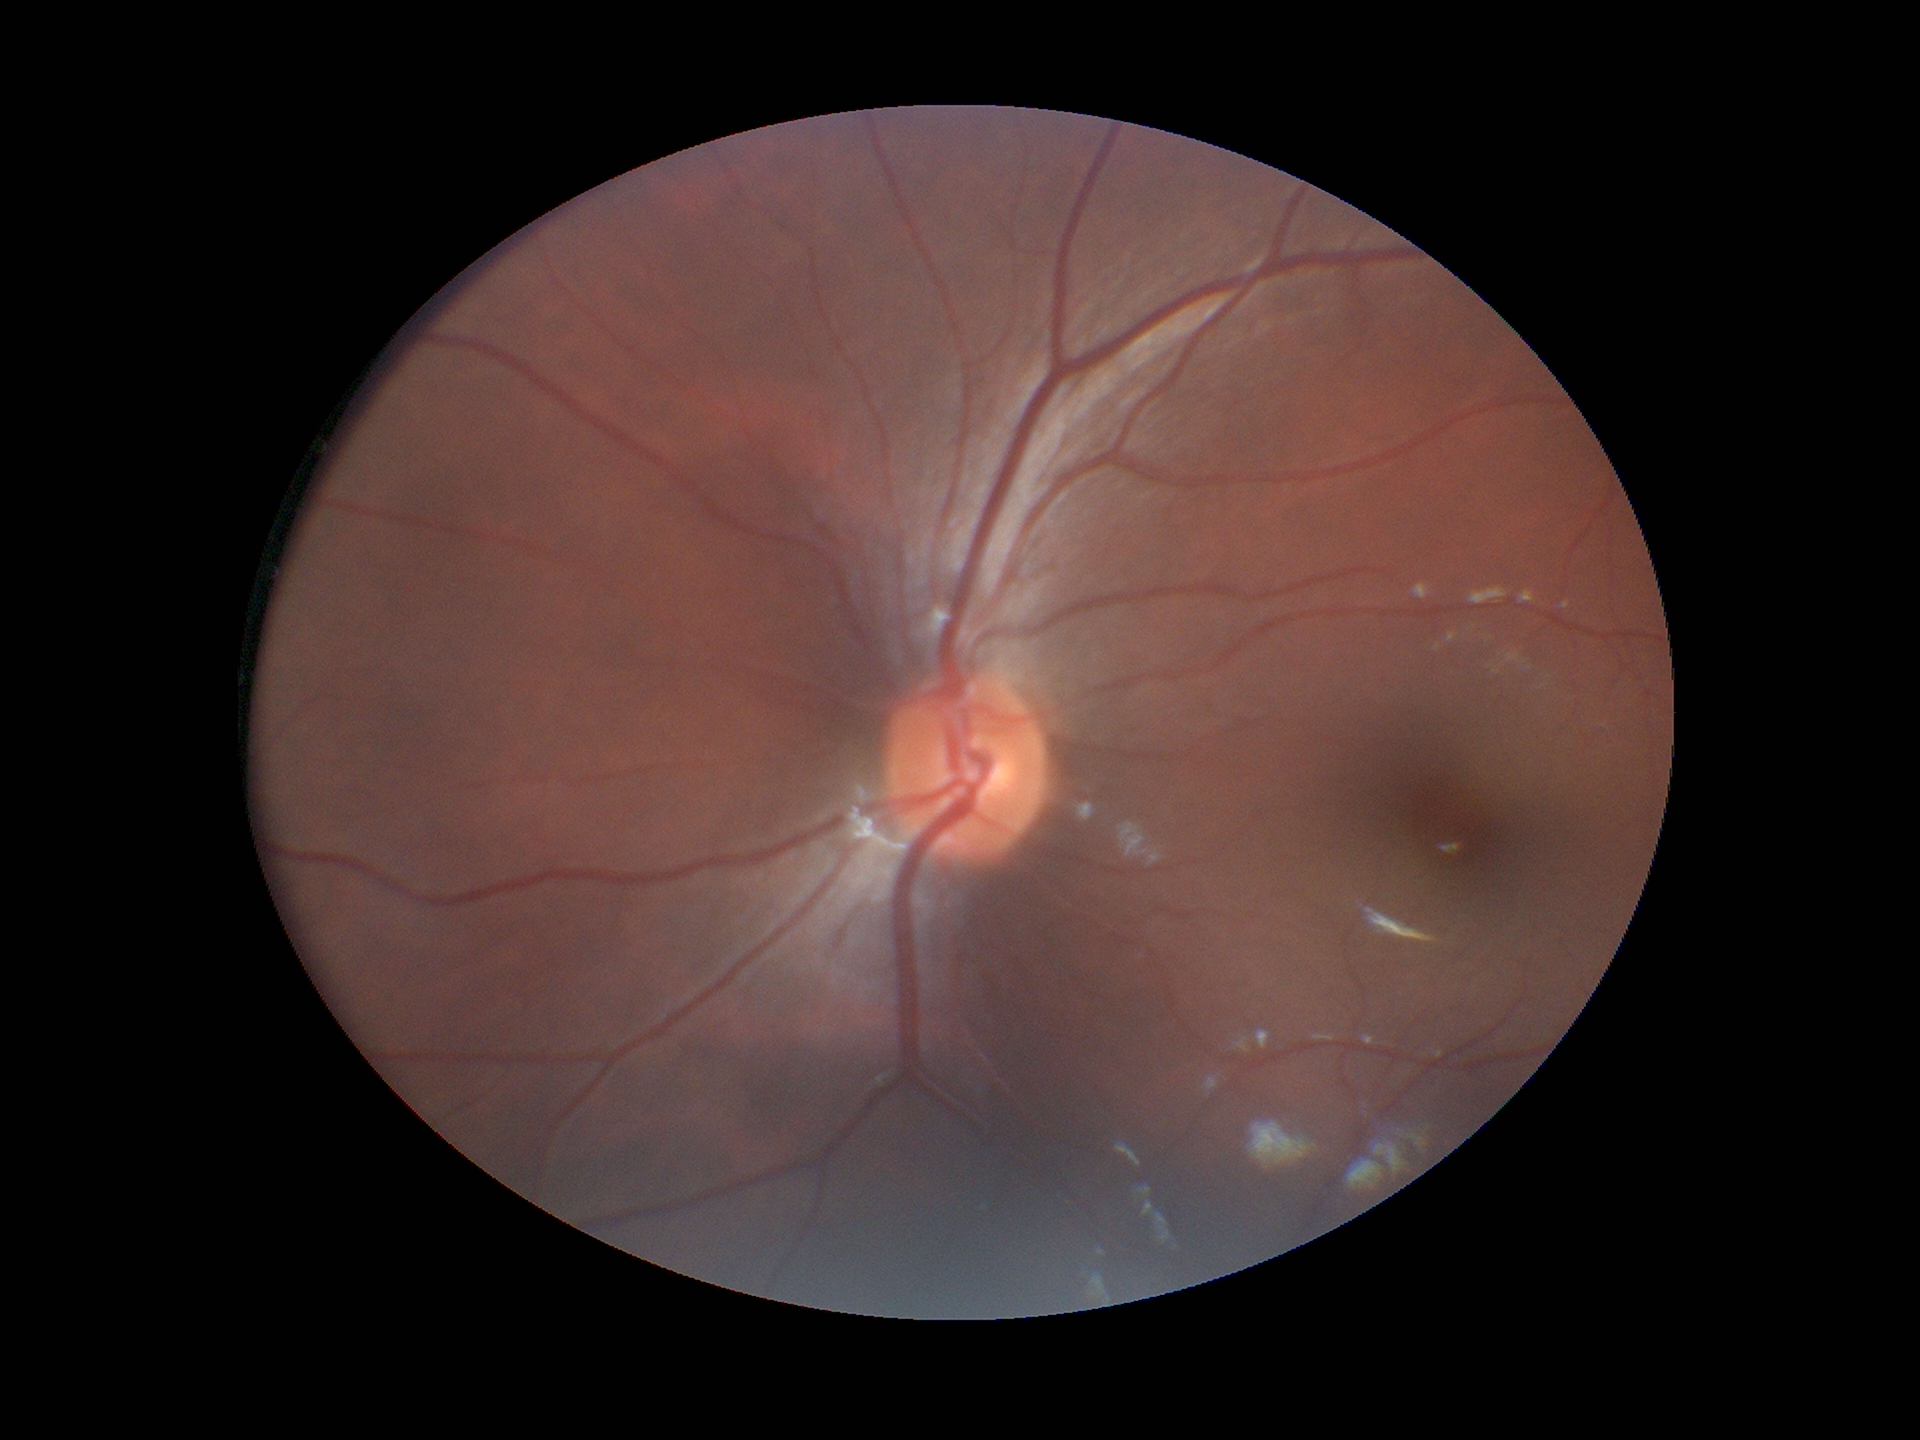

Vertical cup-to-disc ratio: 0.44.
No signs of glaucoma.
Horizontal CDR is 0.49.